Acquired with a Bosch handheld camera · 1920 x 1440 pixels — 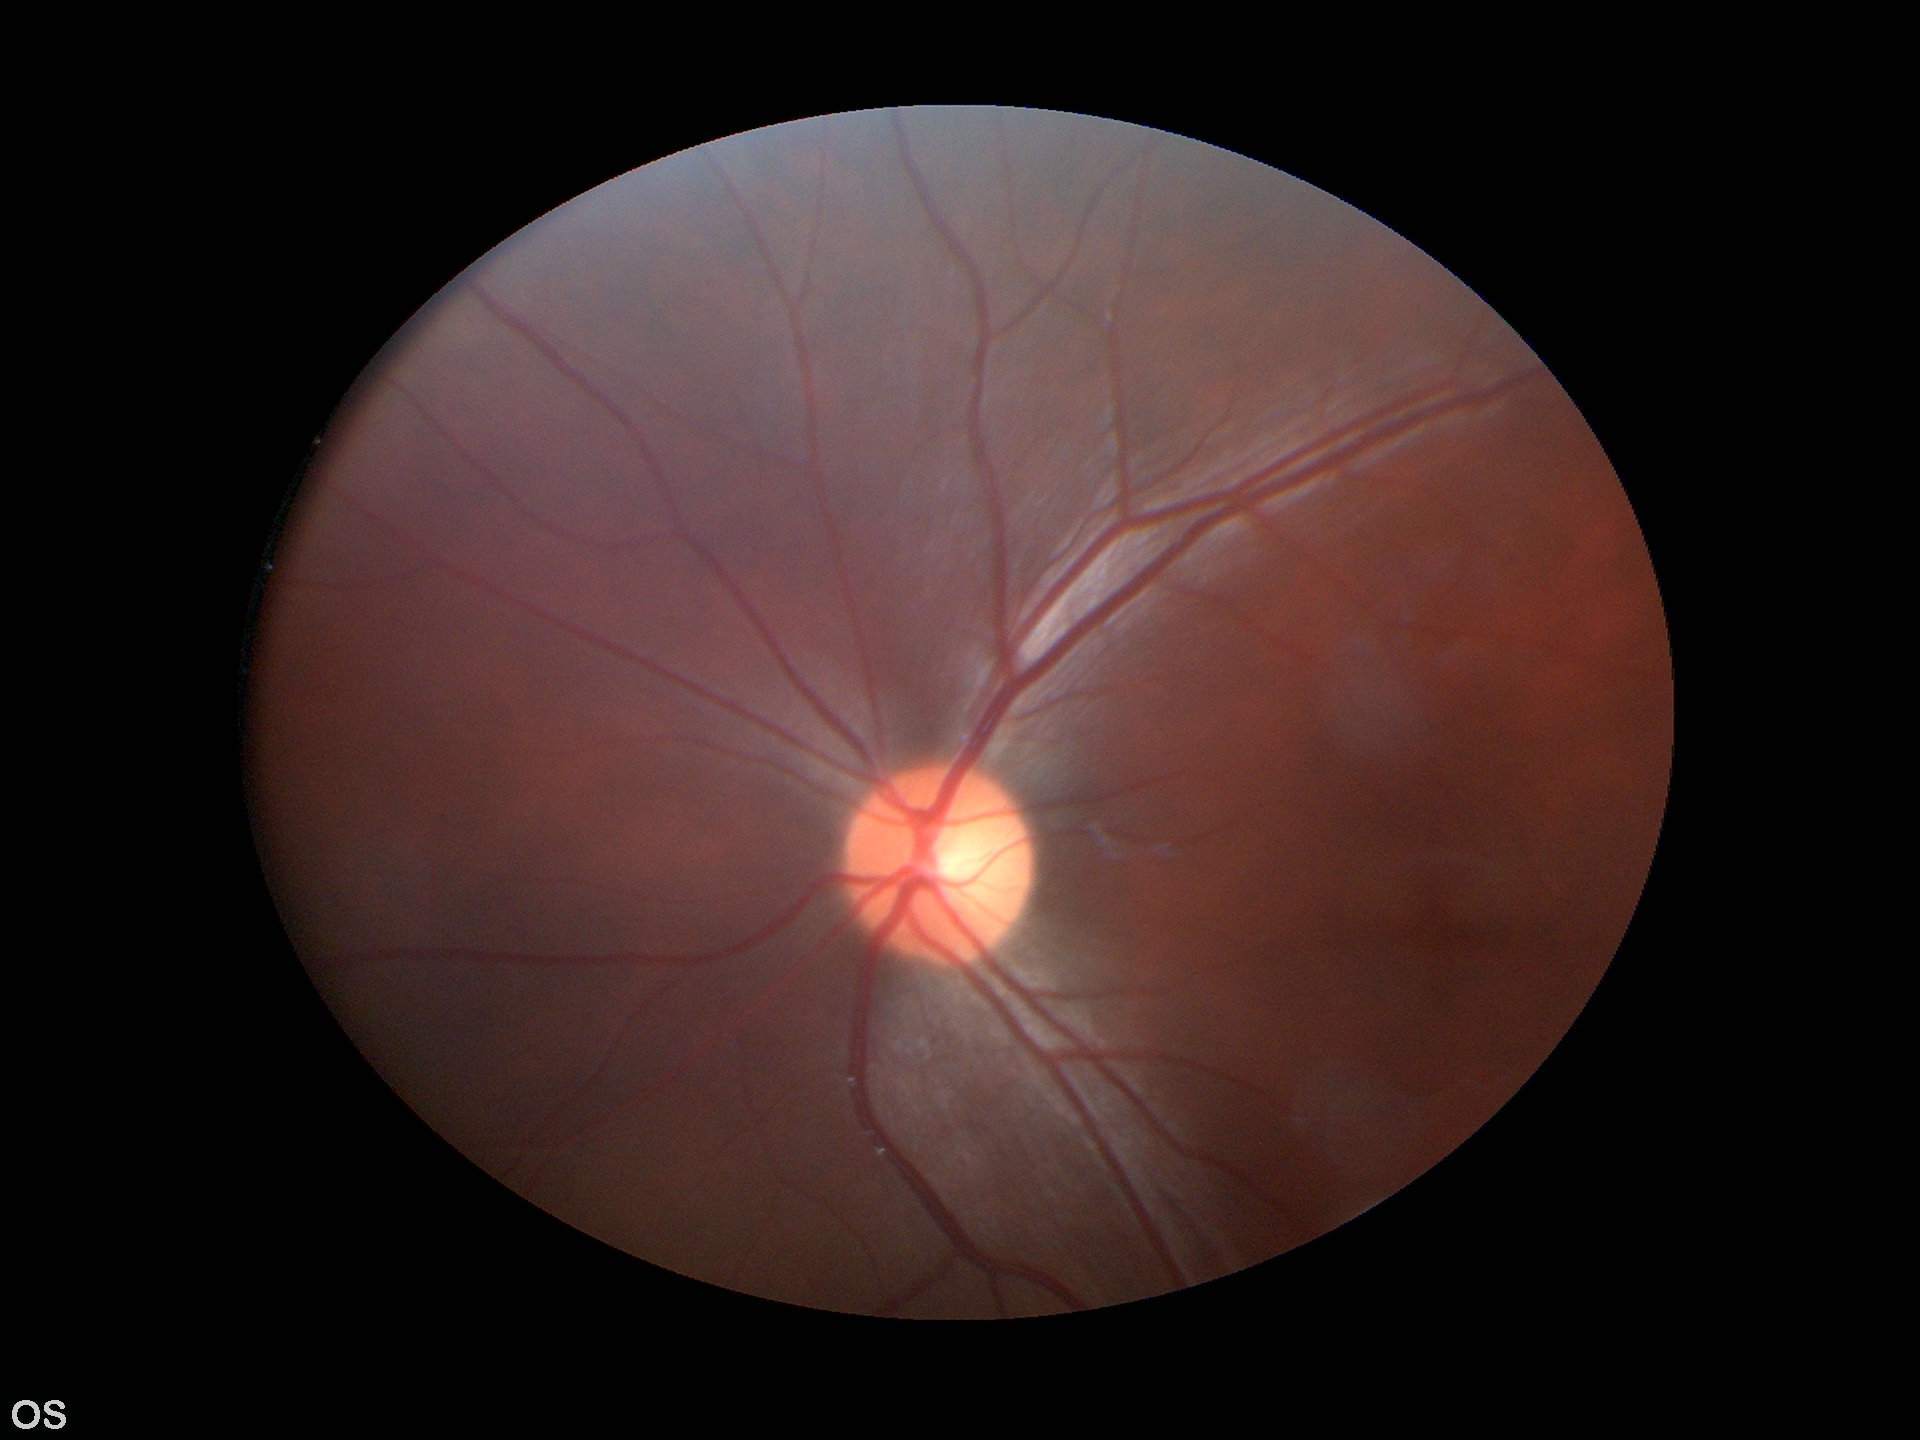

Glaucoma impression: not suspect (5/5 ophthalmologists in agreement).
Vertical cup-disc ratio: 0.47.